Wide-field fundus photograph from neonatal ROP screening · image size 1240x1240.
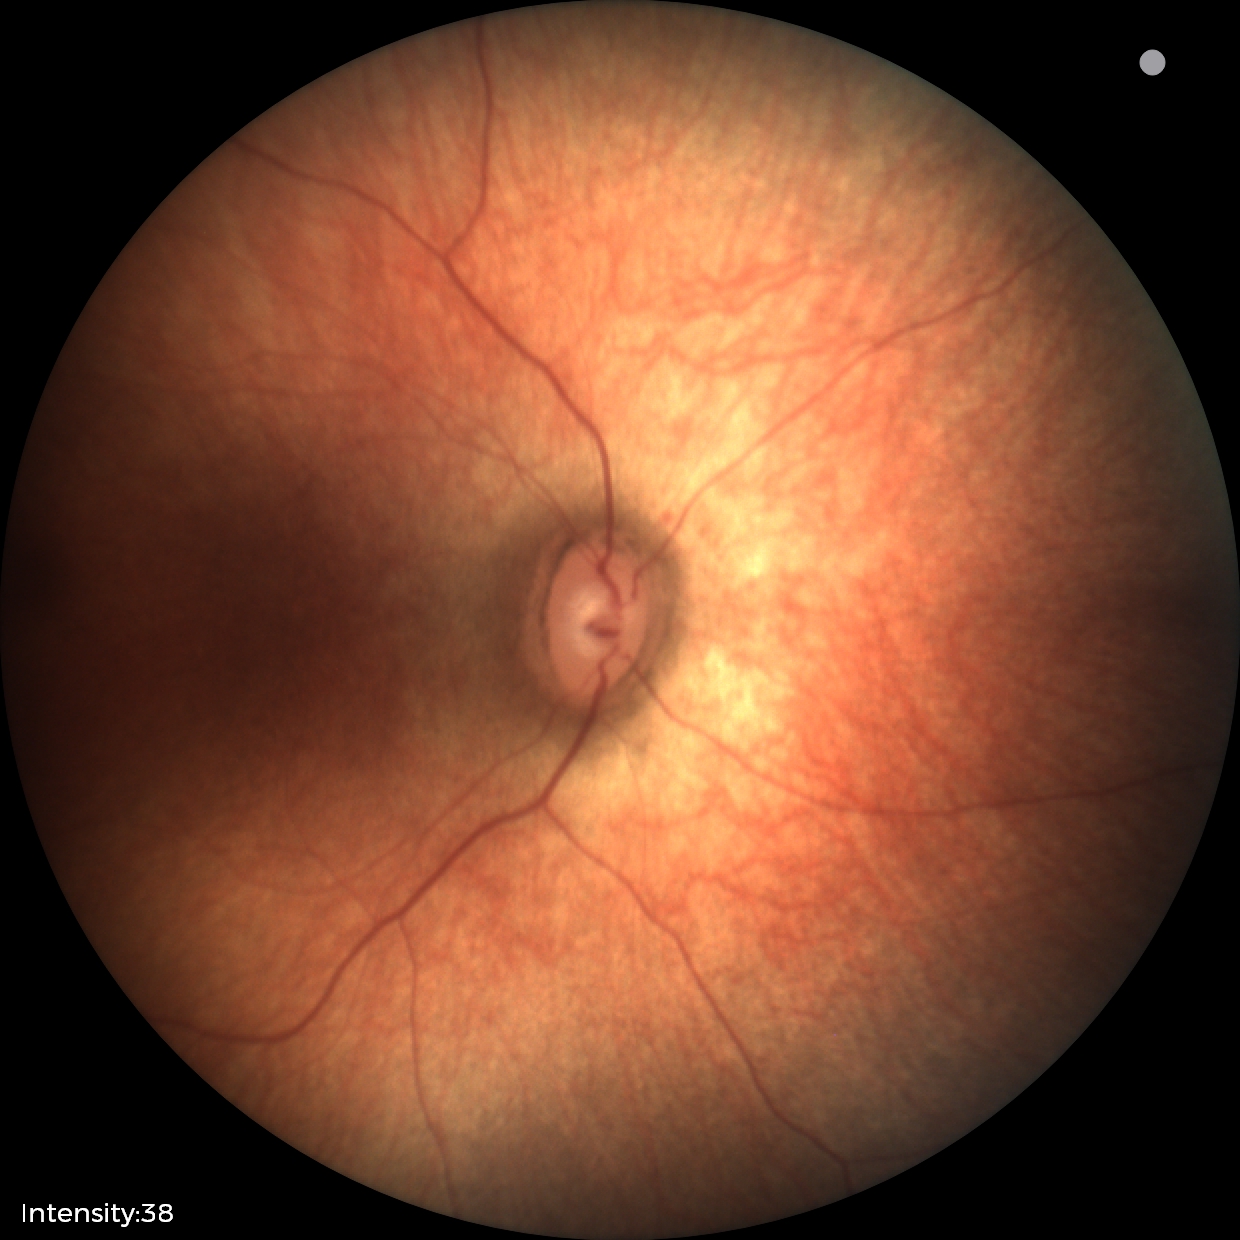
Q: What is the diagnosis from this examination?
A: physiological finding